Color fundus image, captured on a Remidio Fundus on Phone (FOP) camera.
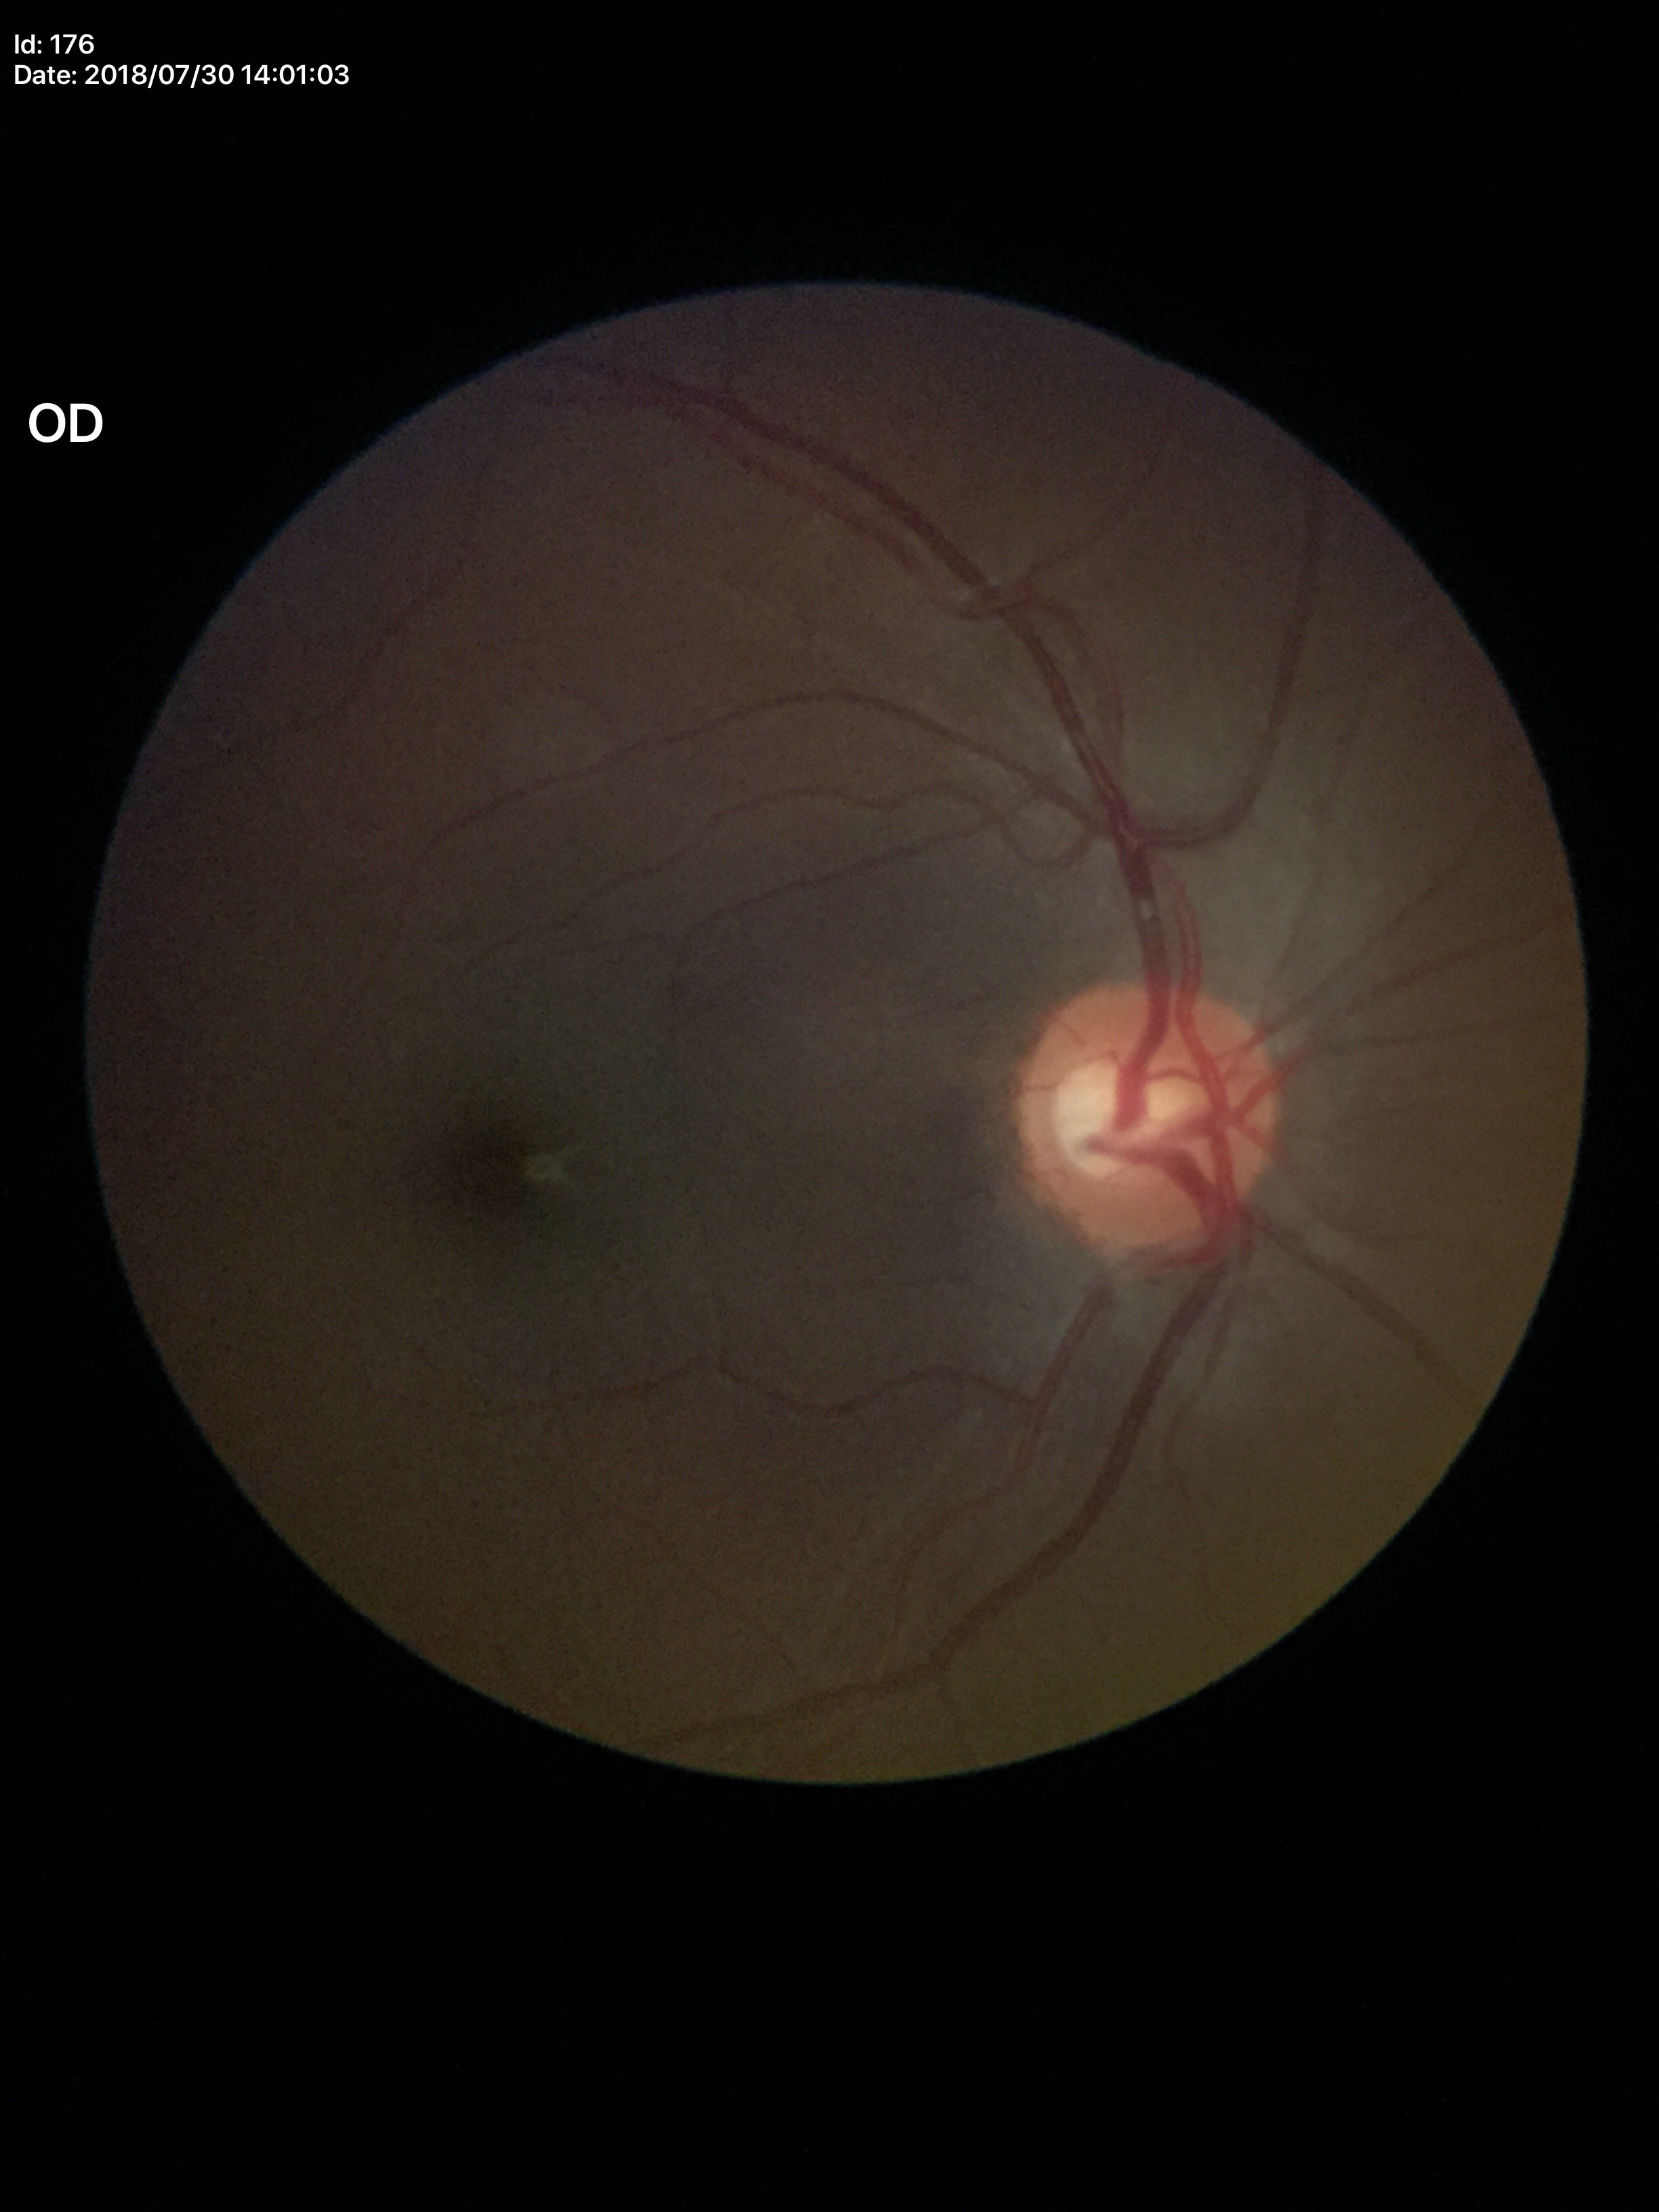

Glaucoma impression=no suspicious findings (unanimous normal call) | vertical cup-disc ratio=0.55 | horizontal C/D ratio=0.63